Color fundus photograph.
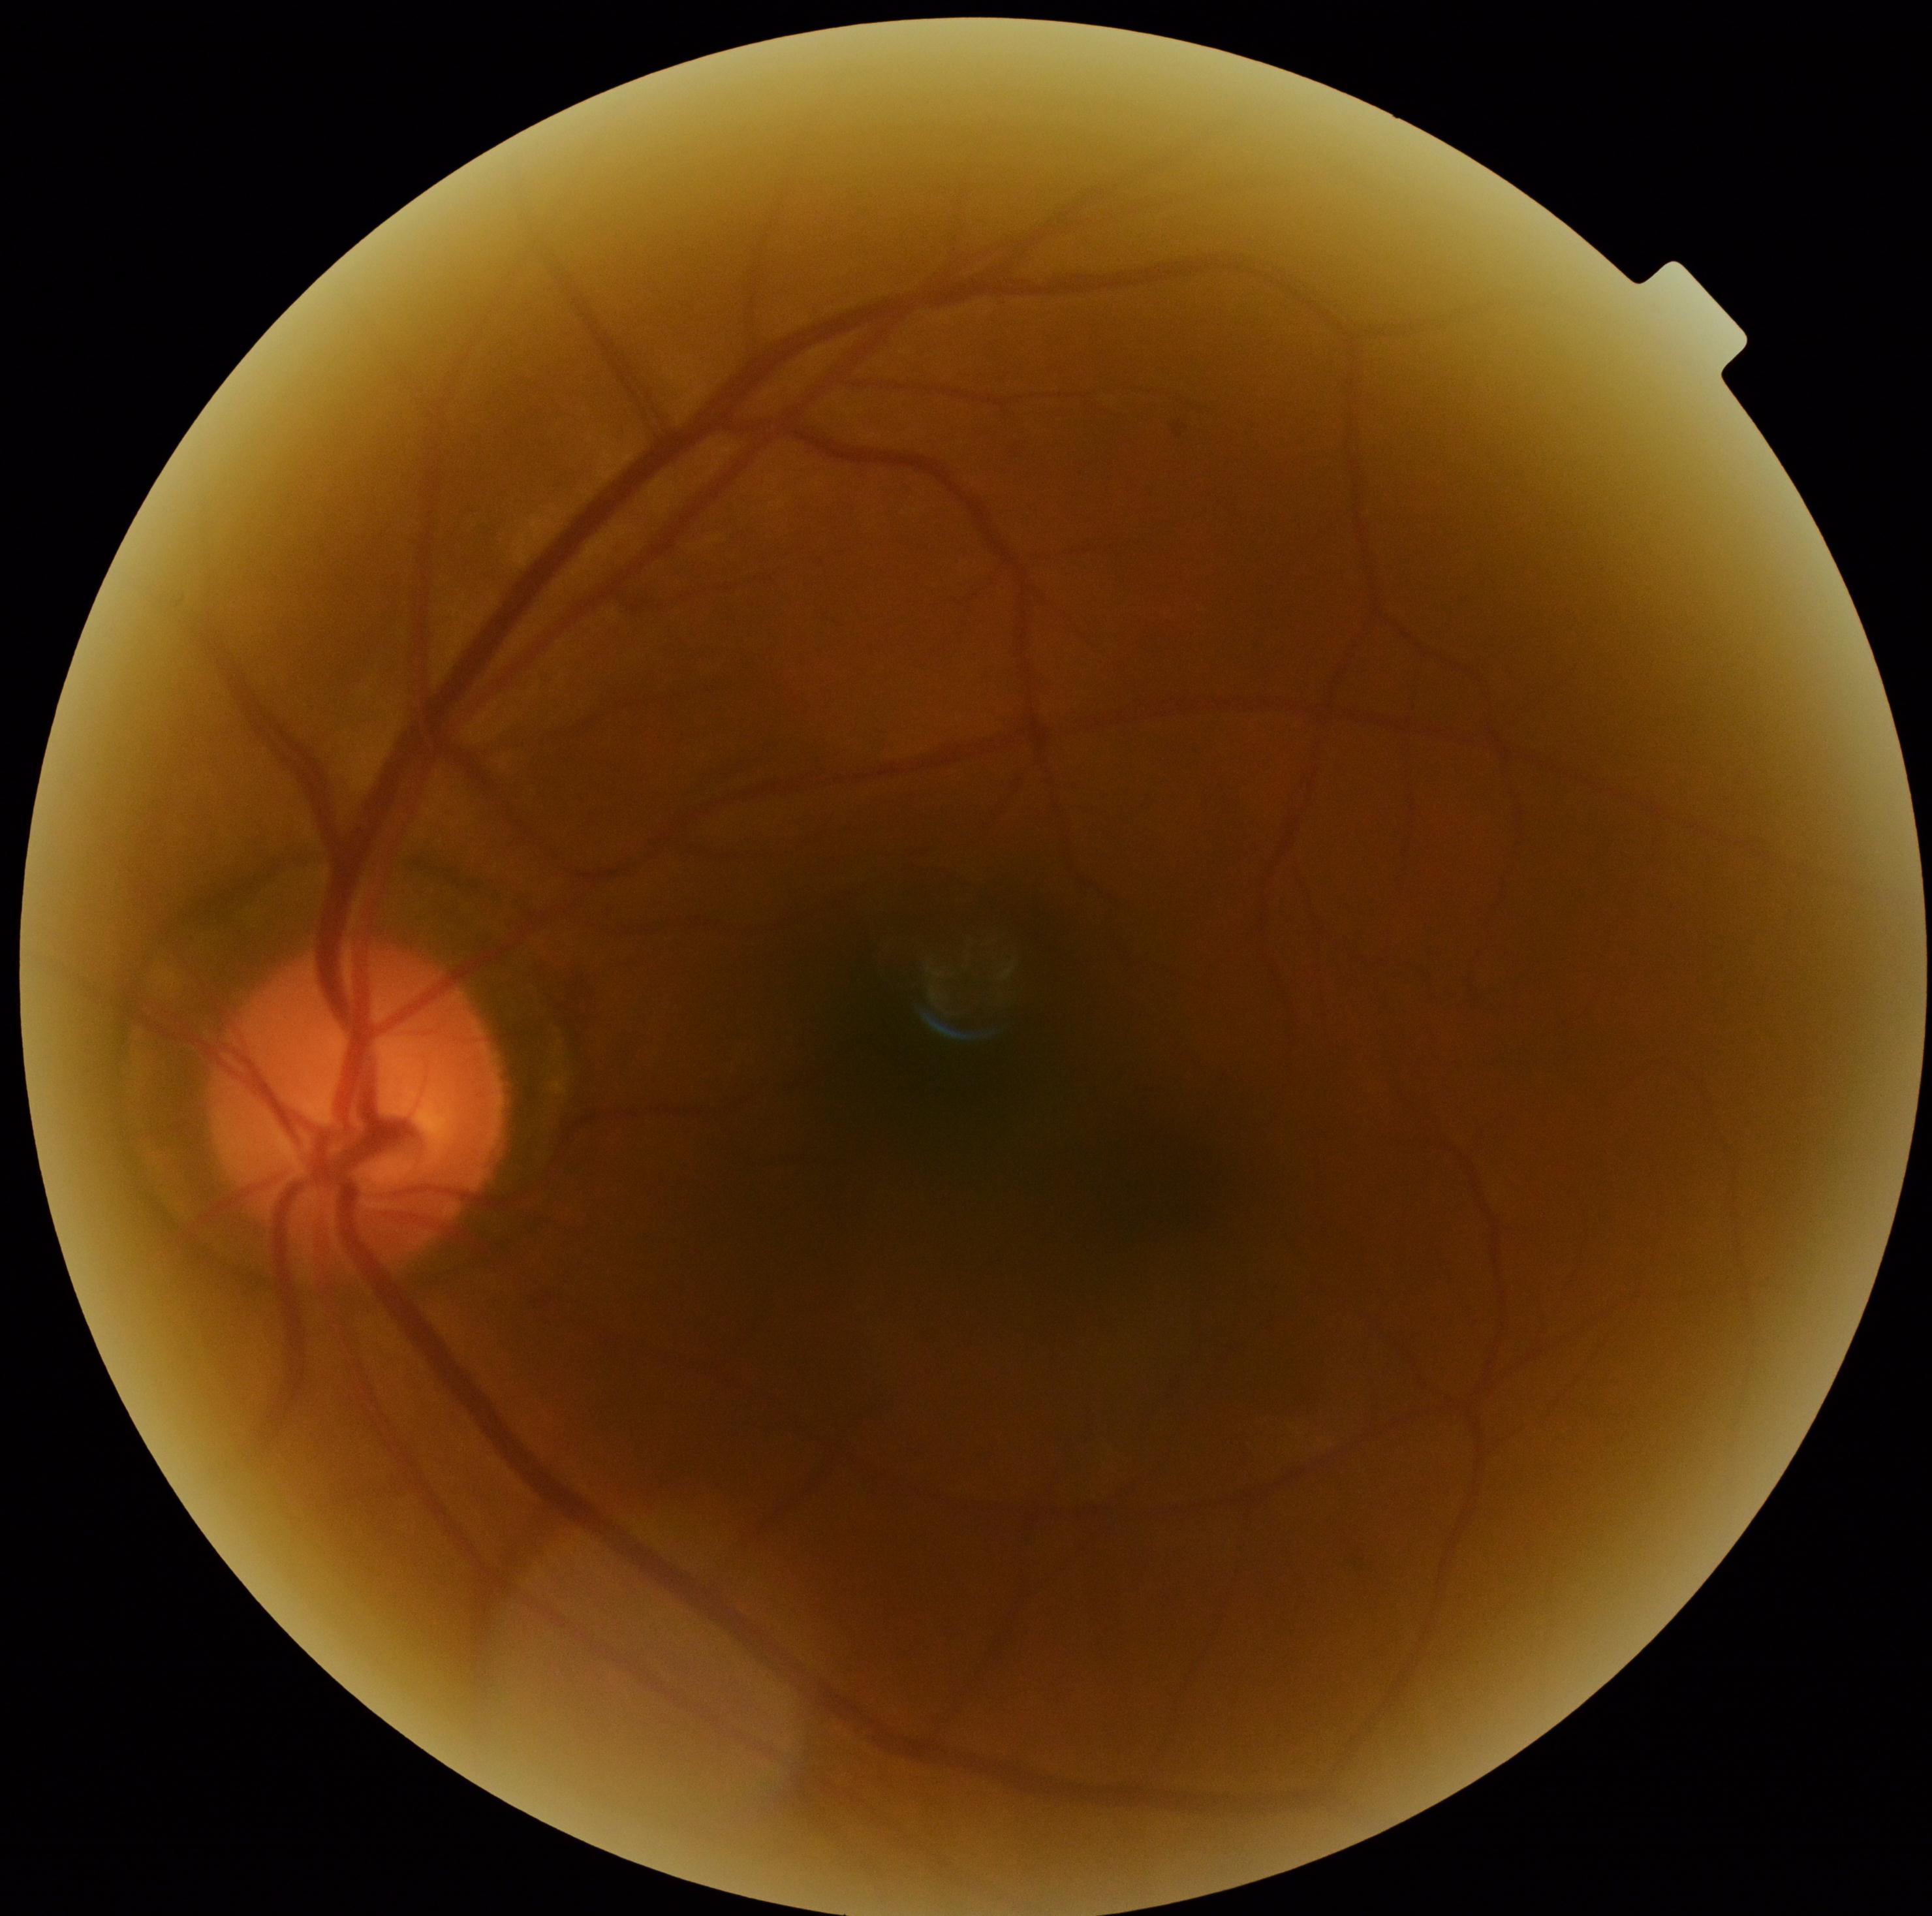

Diabetic retinopathy severity: grade 0 (no apparent retinopathy).